Pediatric retinal photograph (wide-field) — 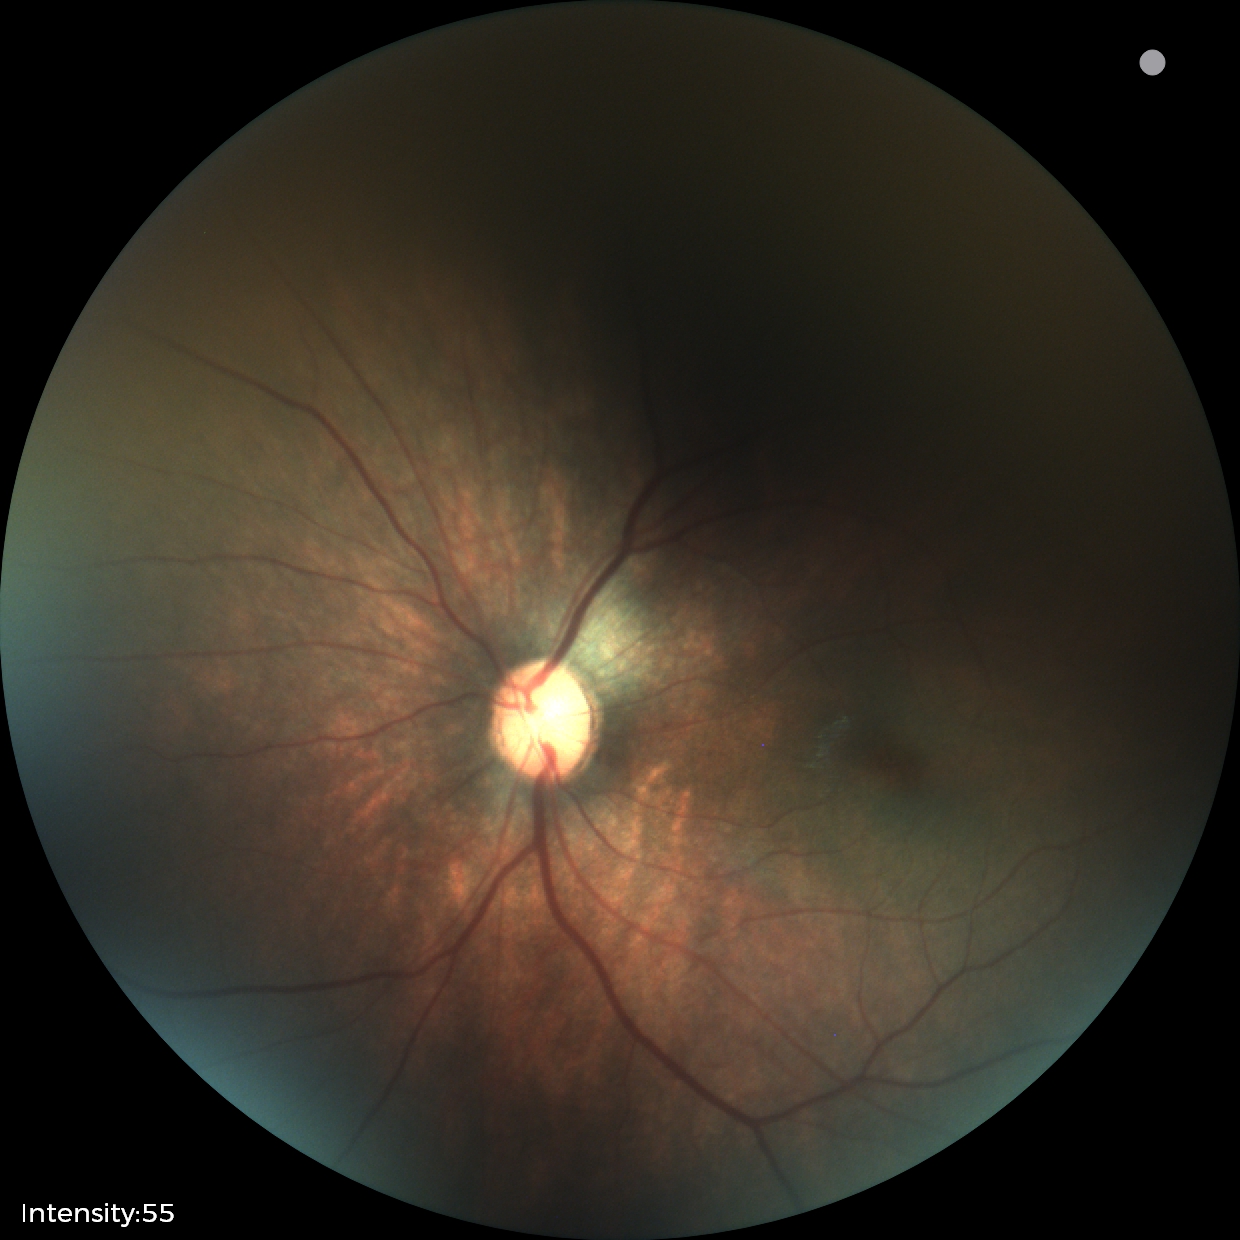

Screening: physiological finding.